848 x 848 pixels — 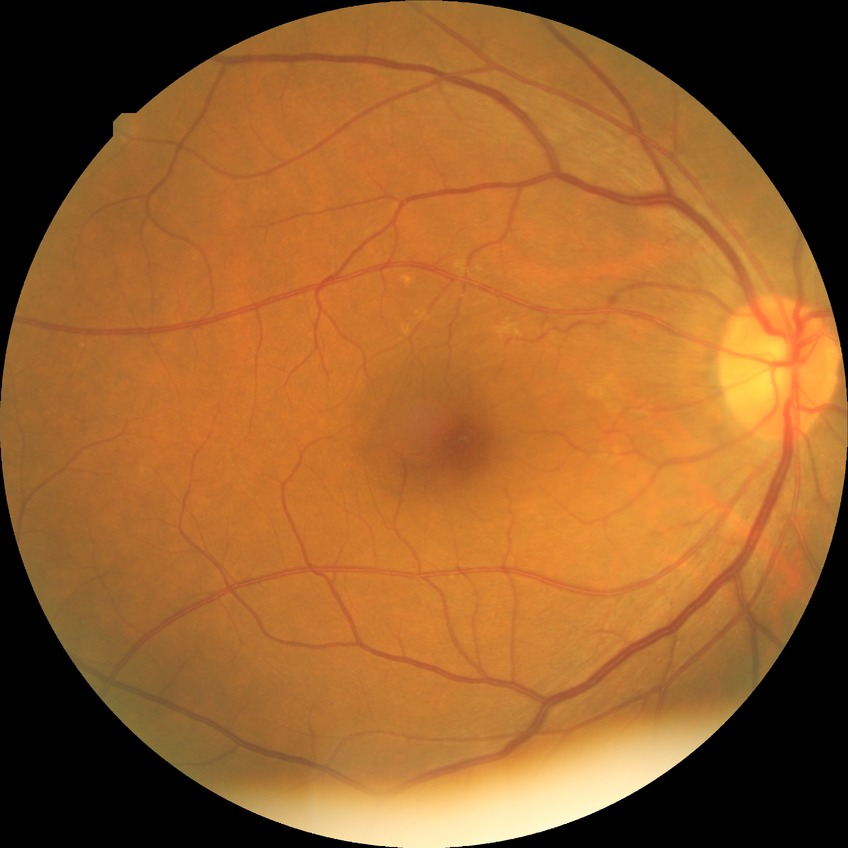
retinopathy grade=no diabetic retinopathy.